Color fundus photograph · acquired with a Bosch handheld camera:
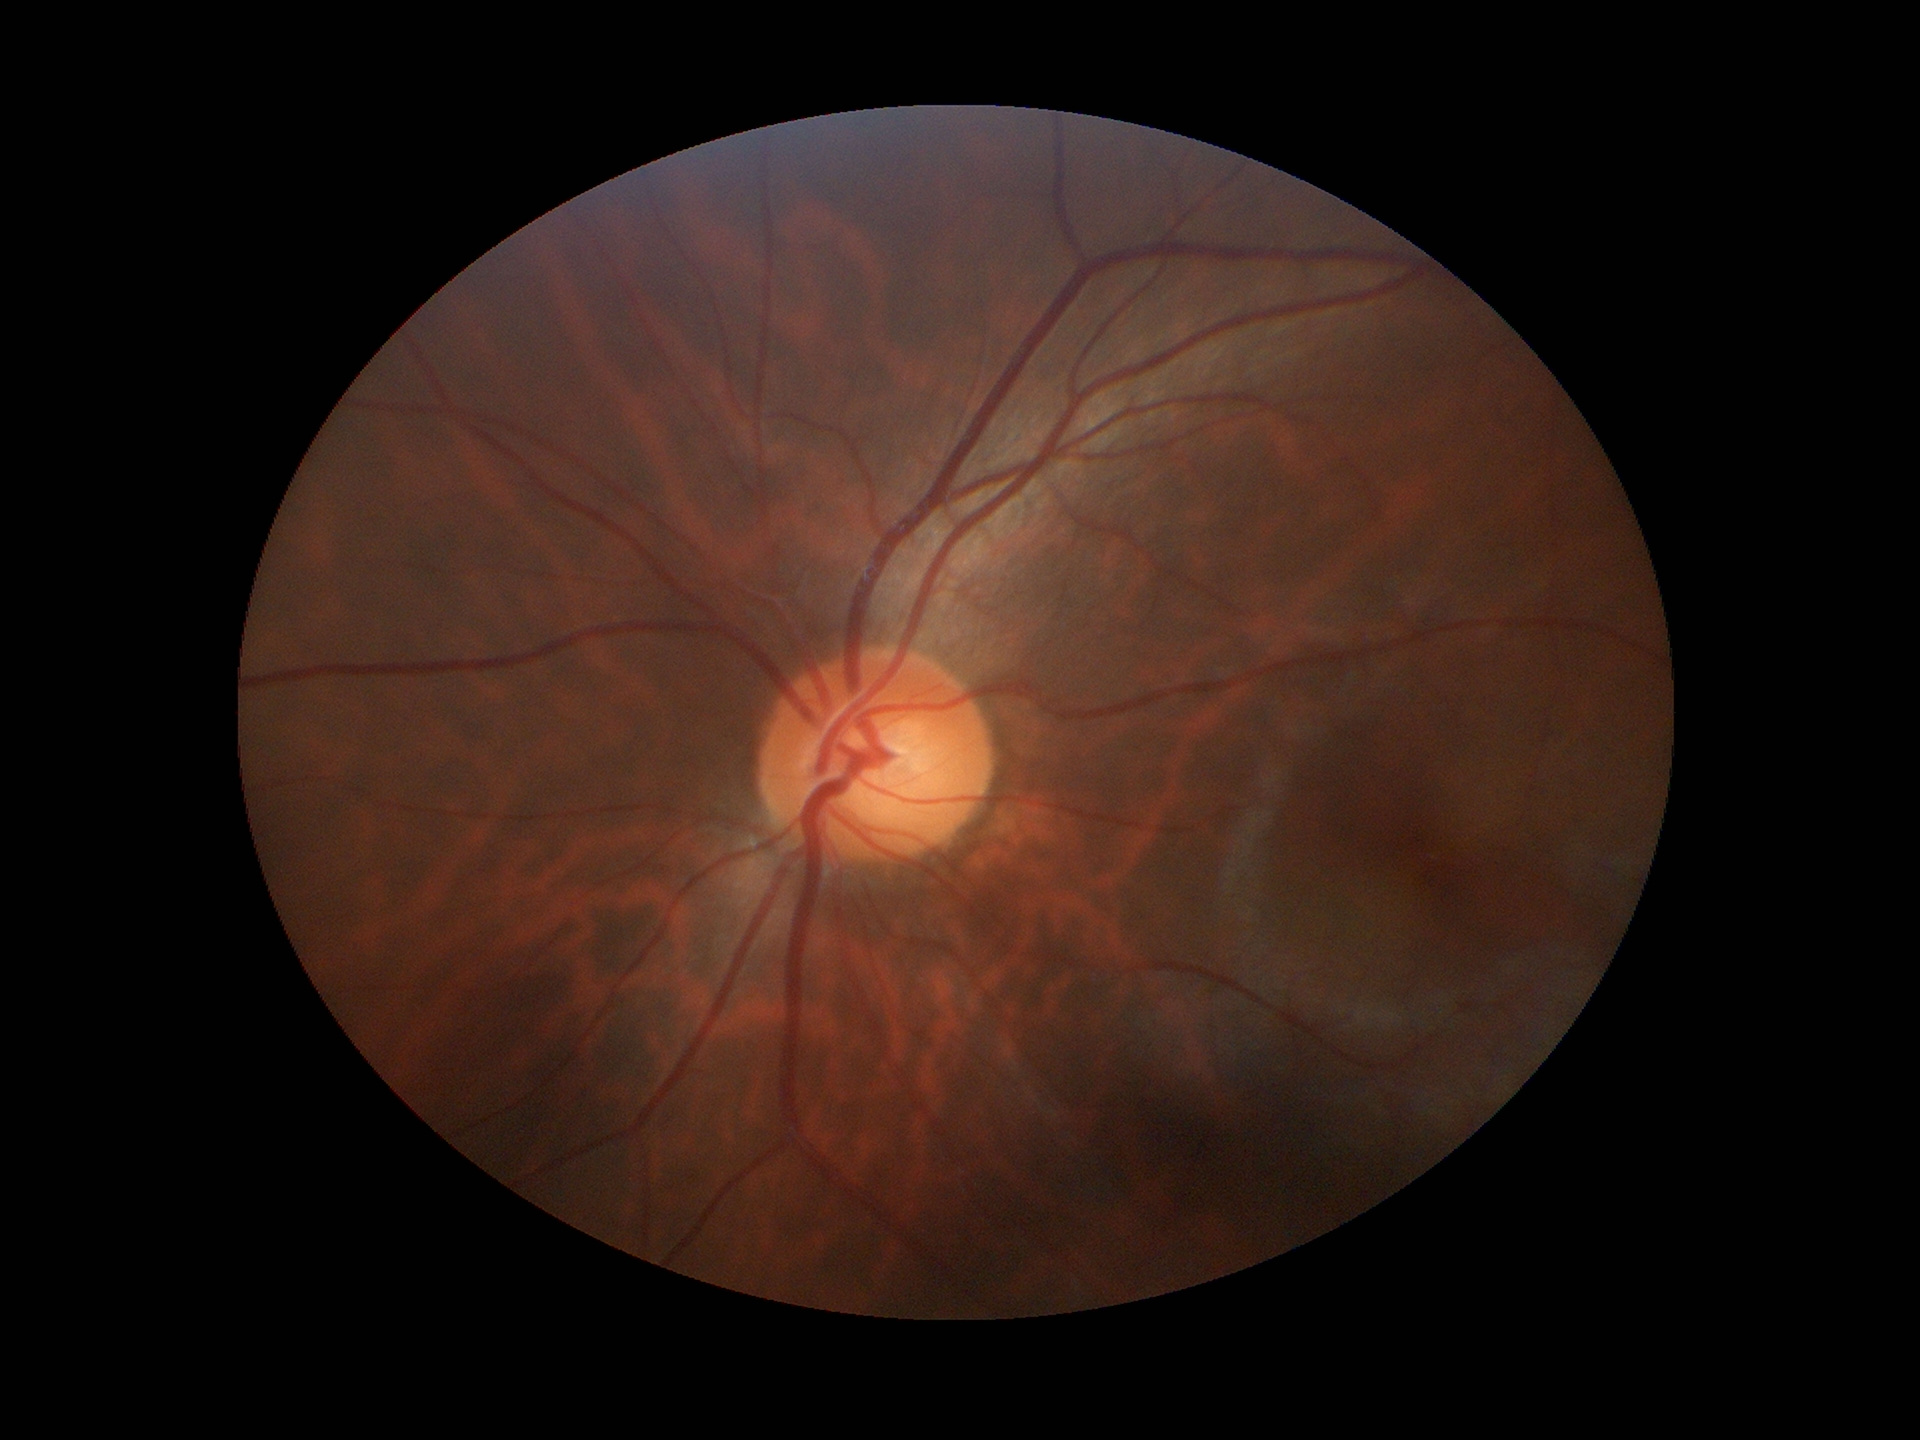 Glaucoma screening impression: no suspicious findings. Vertical cup-disc ratio (VCDR) of 0.54.